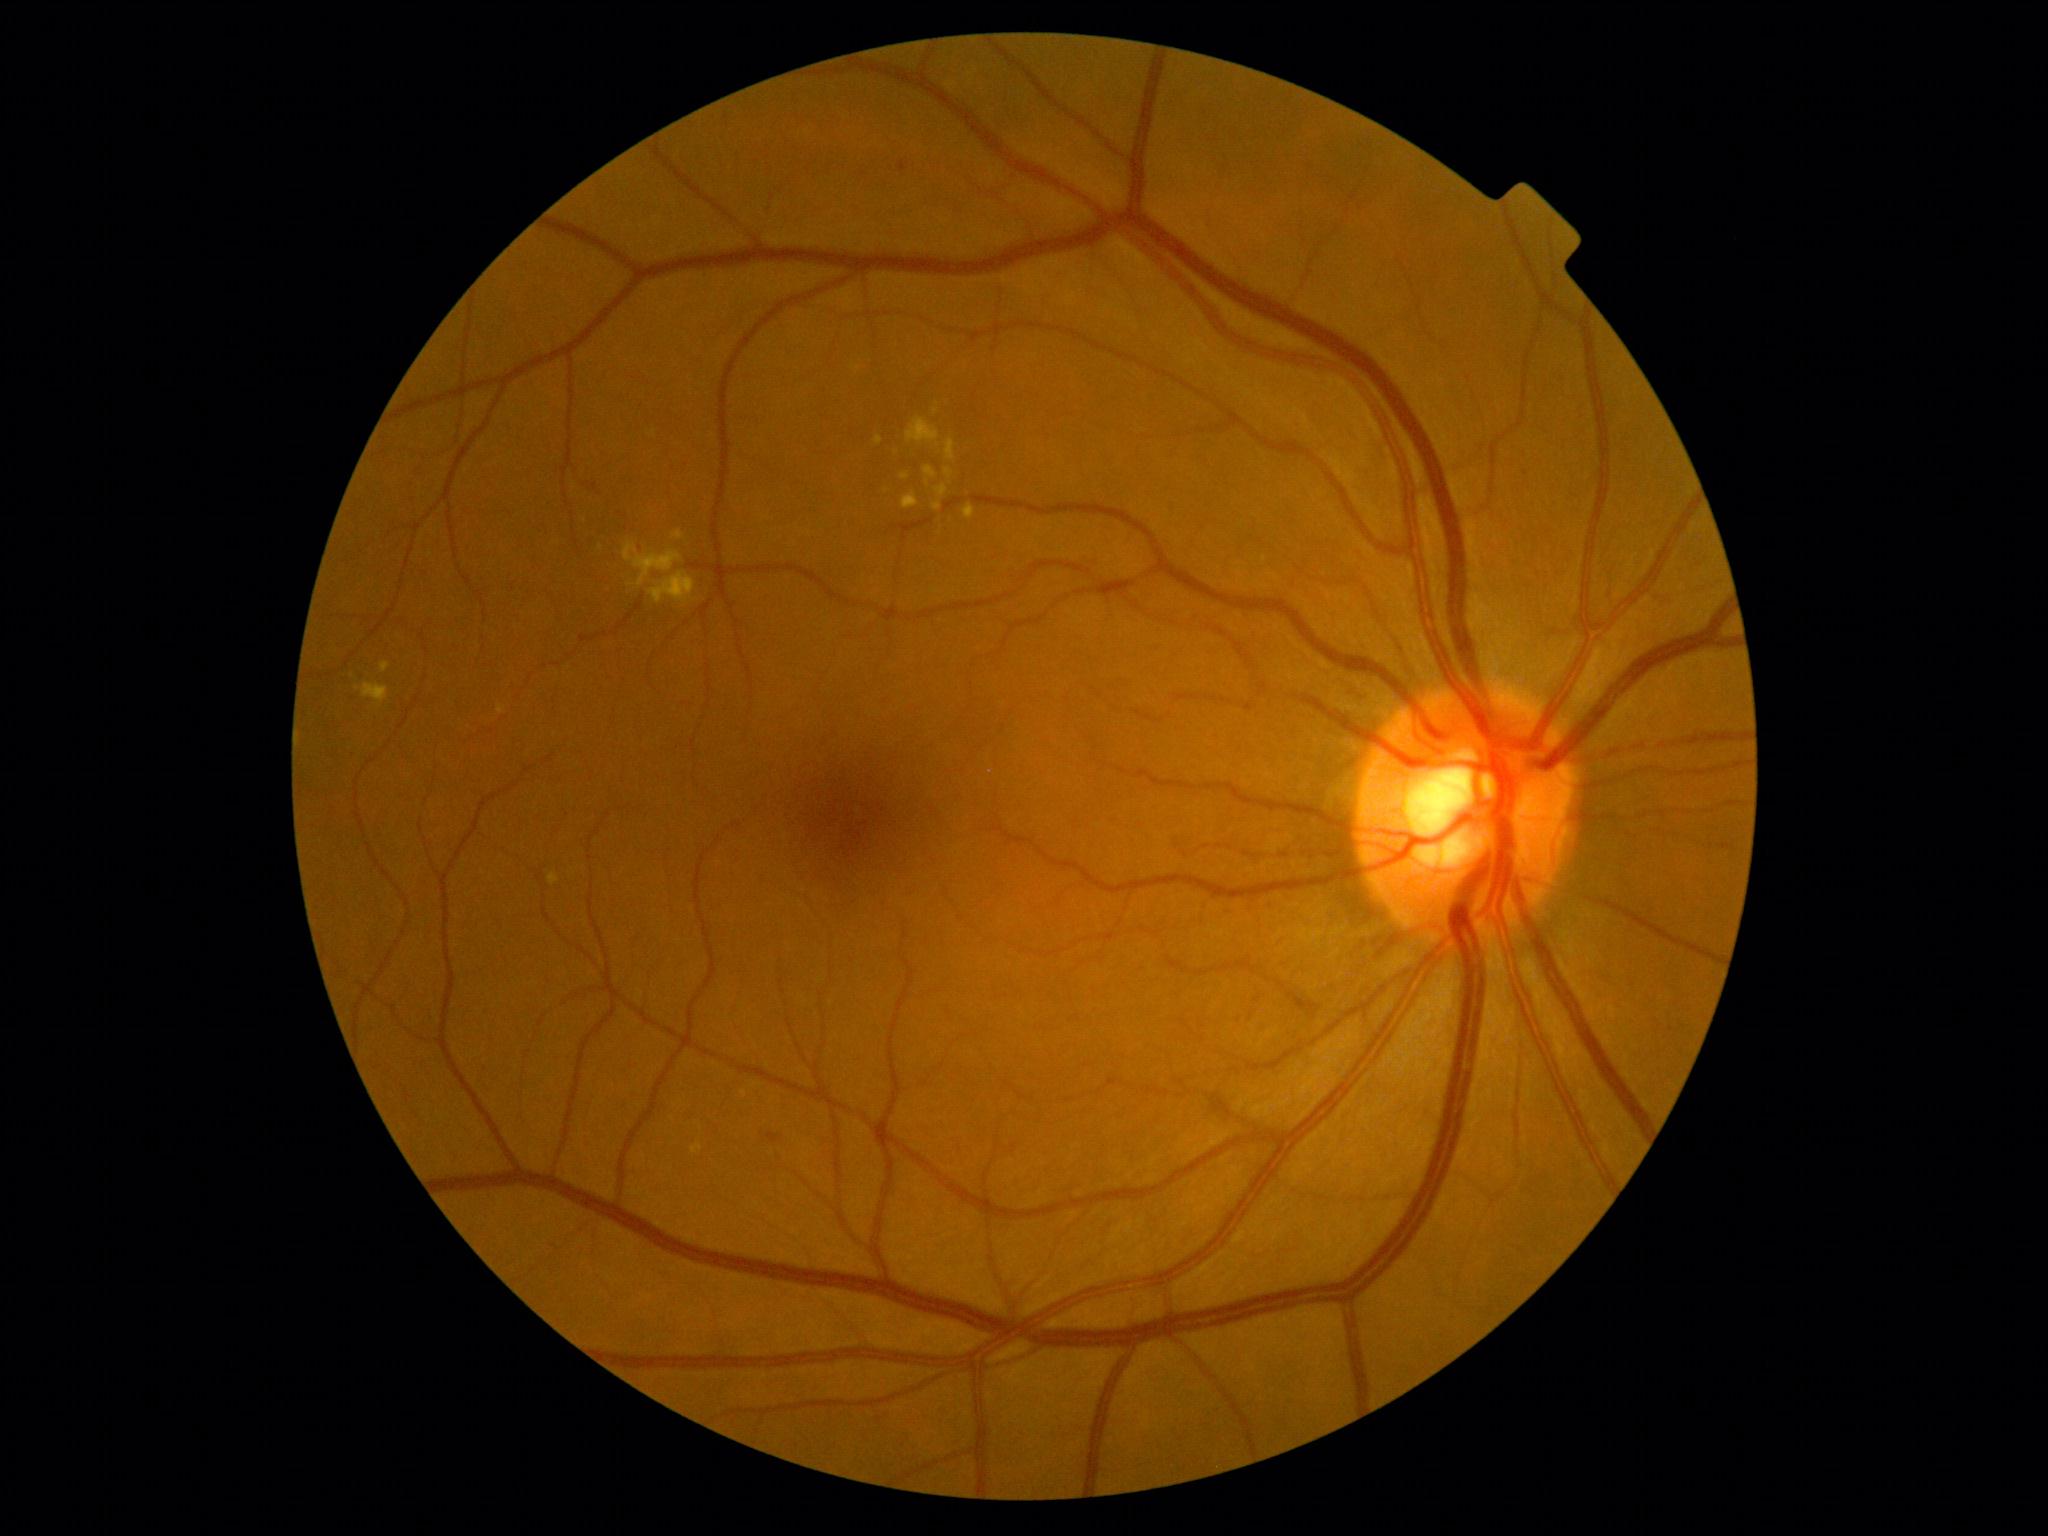
Diabetic retinopathy severity: grade 2
Lesions identified (partial list):
soft exudates: not present
hard exudates (more not shown): left=691, top=1144, right=703, bottom=1154, left=624, top=543, right=683, bottom=589, left=498, top=706, right=505, bottom=715, left=933, top=501, right=942, bottom=511, left=673, top=531, right=684, bottom=540, left=906, top=418, right=941, bottom=444, left=946, top=440, right=956, bottom=461, left=935, top=485, right=948, bottom=497, left=923, top=467, right=938, bottom=487
Additional small hard exudates near point(937, 403), point(935, 412)
hemorrhages: left=767, top=1133, right=783, bottom=1143, left=588, top=474, right=607, bottom=497
microaneurysms: left=898, top=162, right=908, bottom=173